Infant wide-field retinal image.
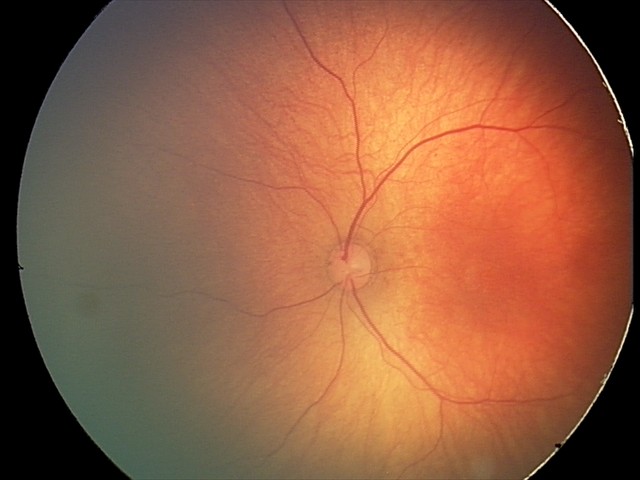
Screening diagnosis: normal fundus examination.